45° field of view. Fundus photo. 2352 x 1568 pixels.
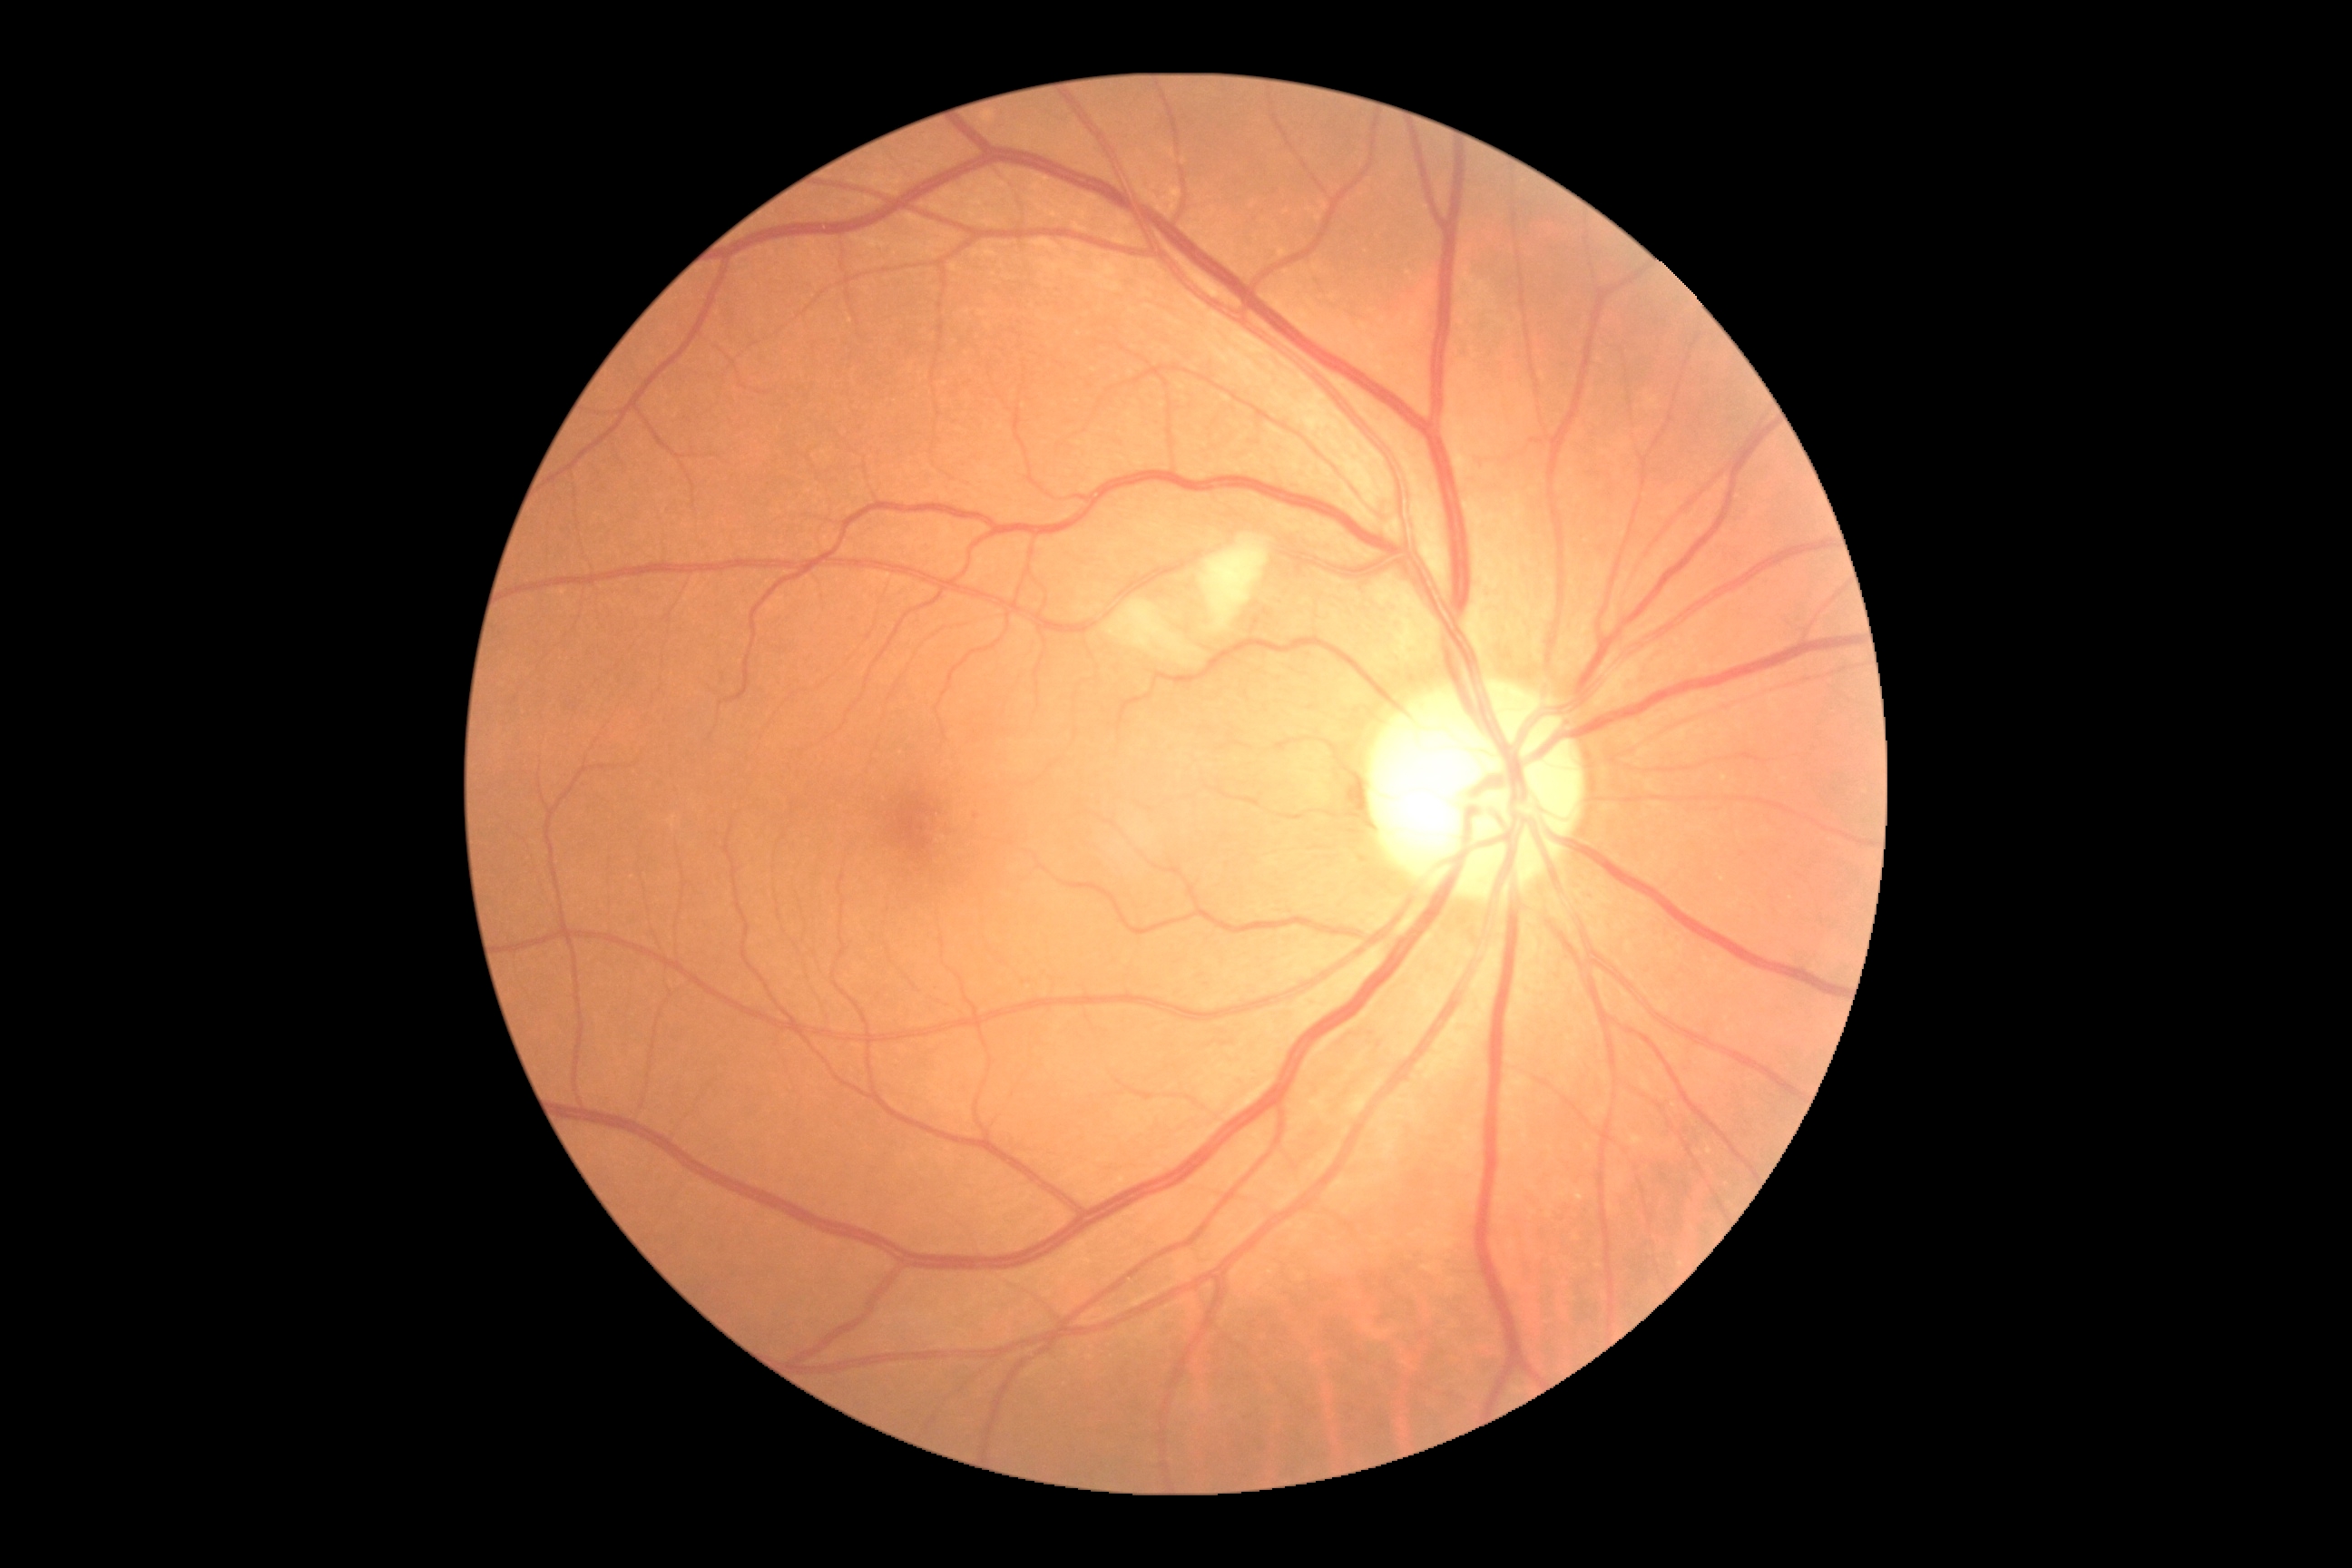

Annotations:
* diabetic retinopathy grade — 2